Wide-field fundus photograph from neonatal ROP screening; 1240 x 1240 pixels: 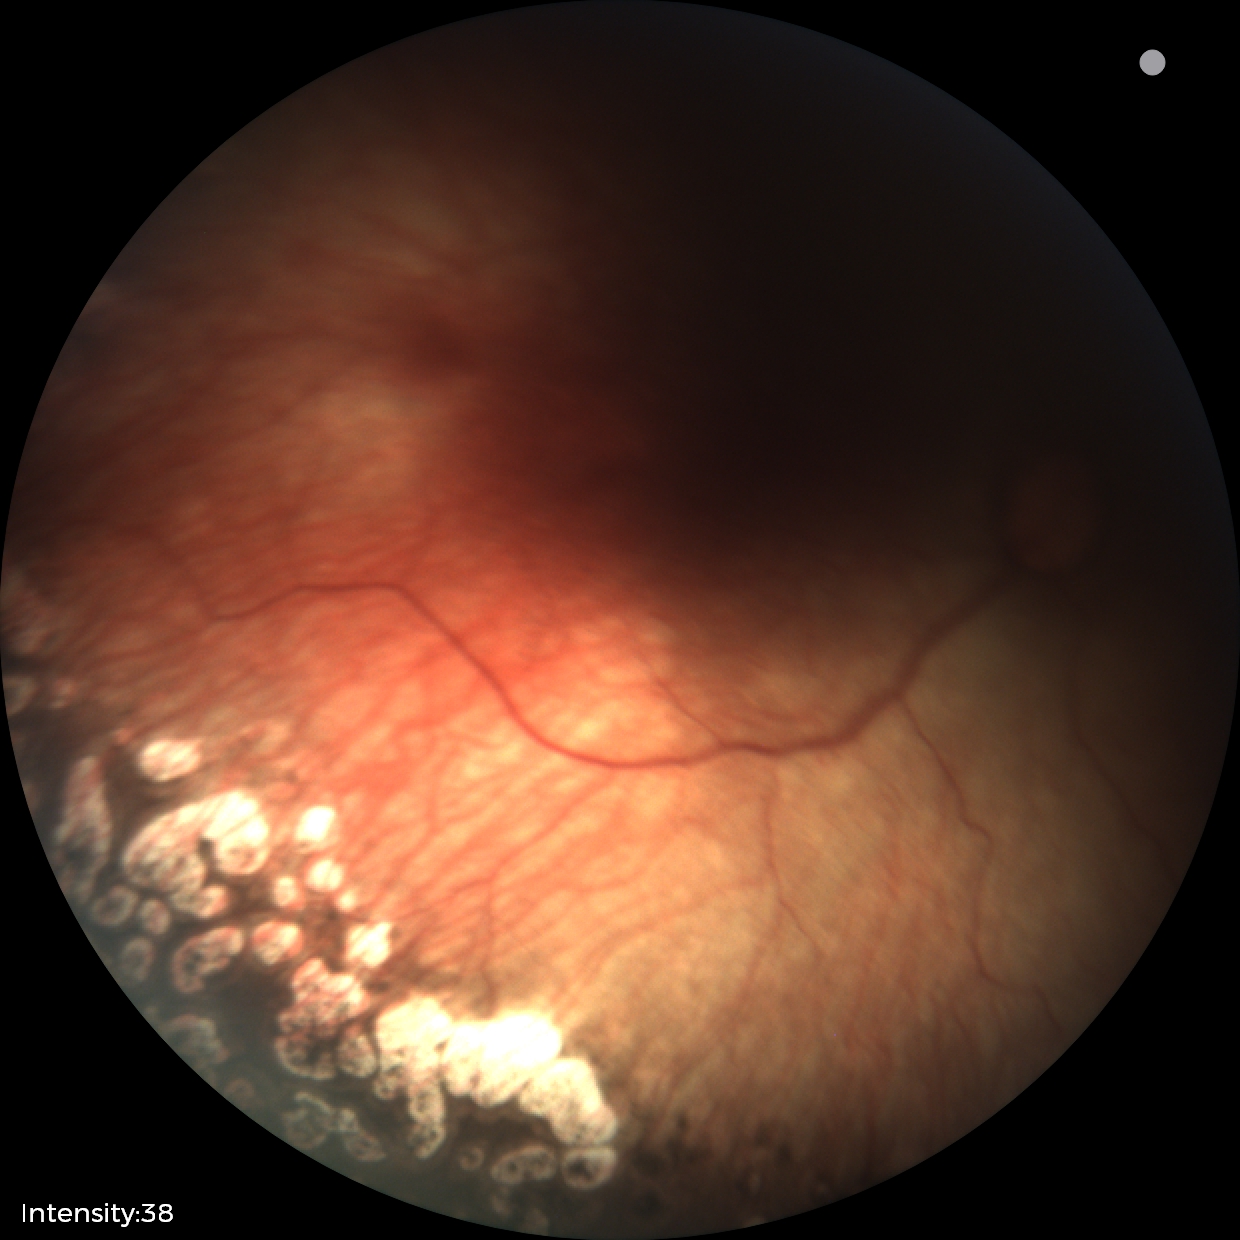
Impression: no plus disease; status post retinopathy of prematurity.